Color fundus image. 2346 x 1568 pixels. 45-degree field of view: 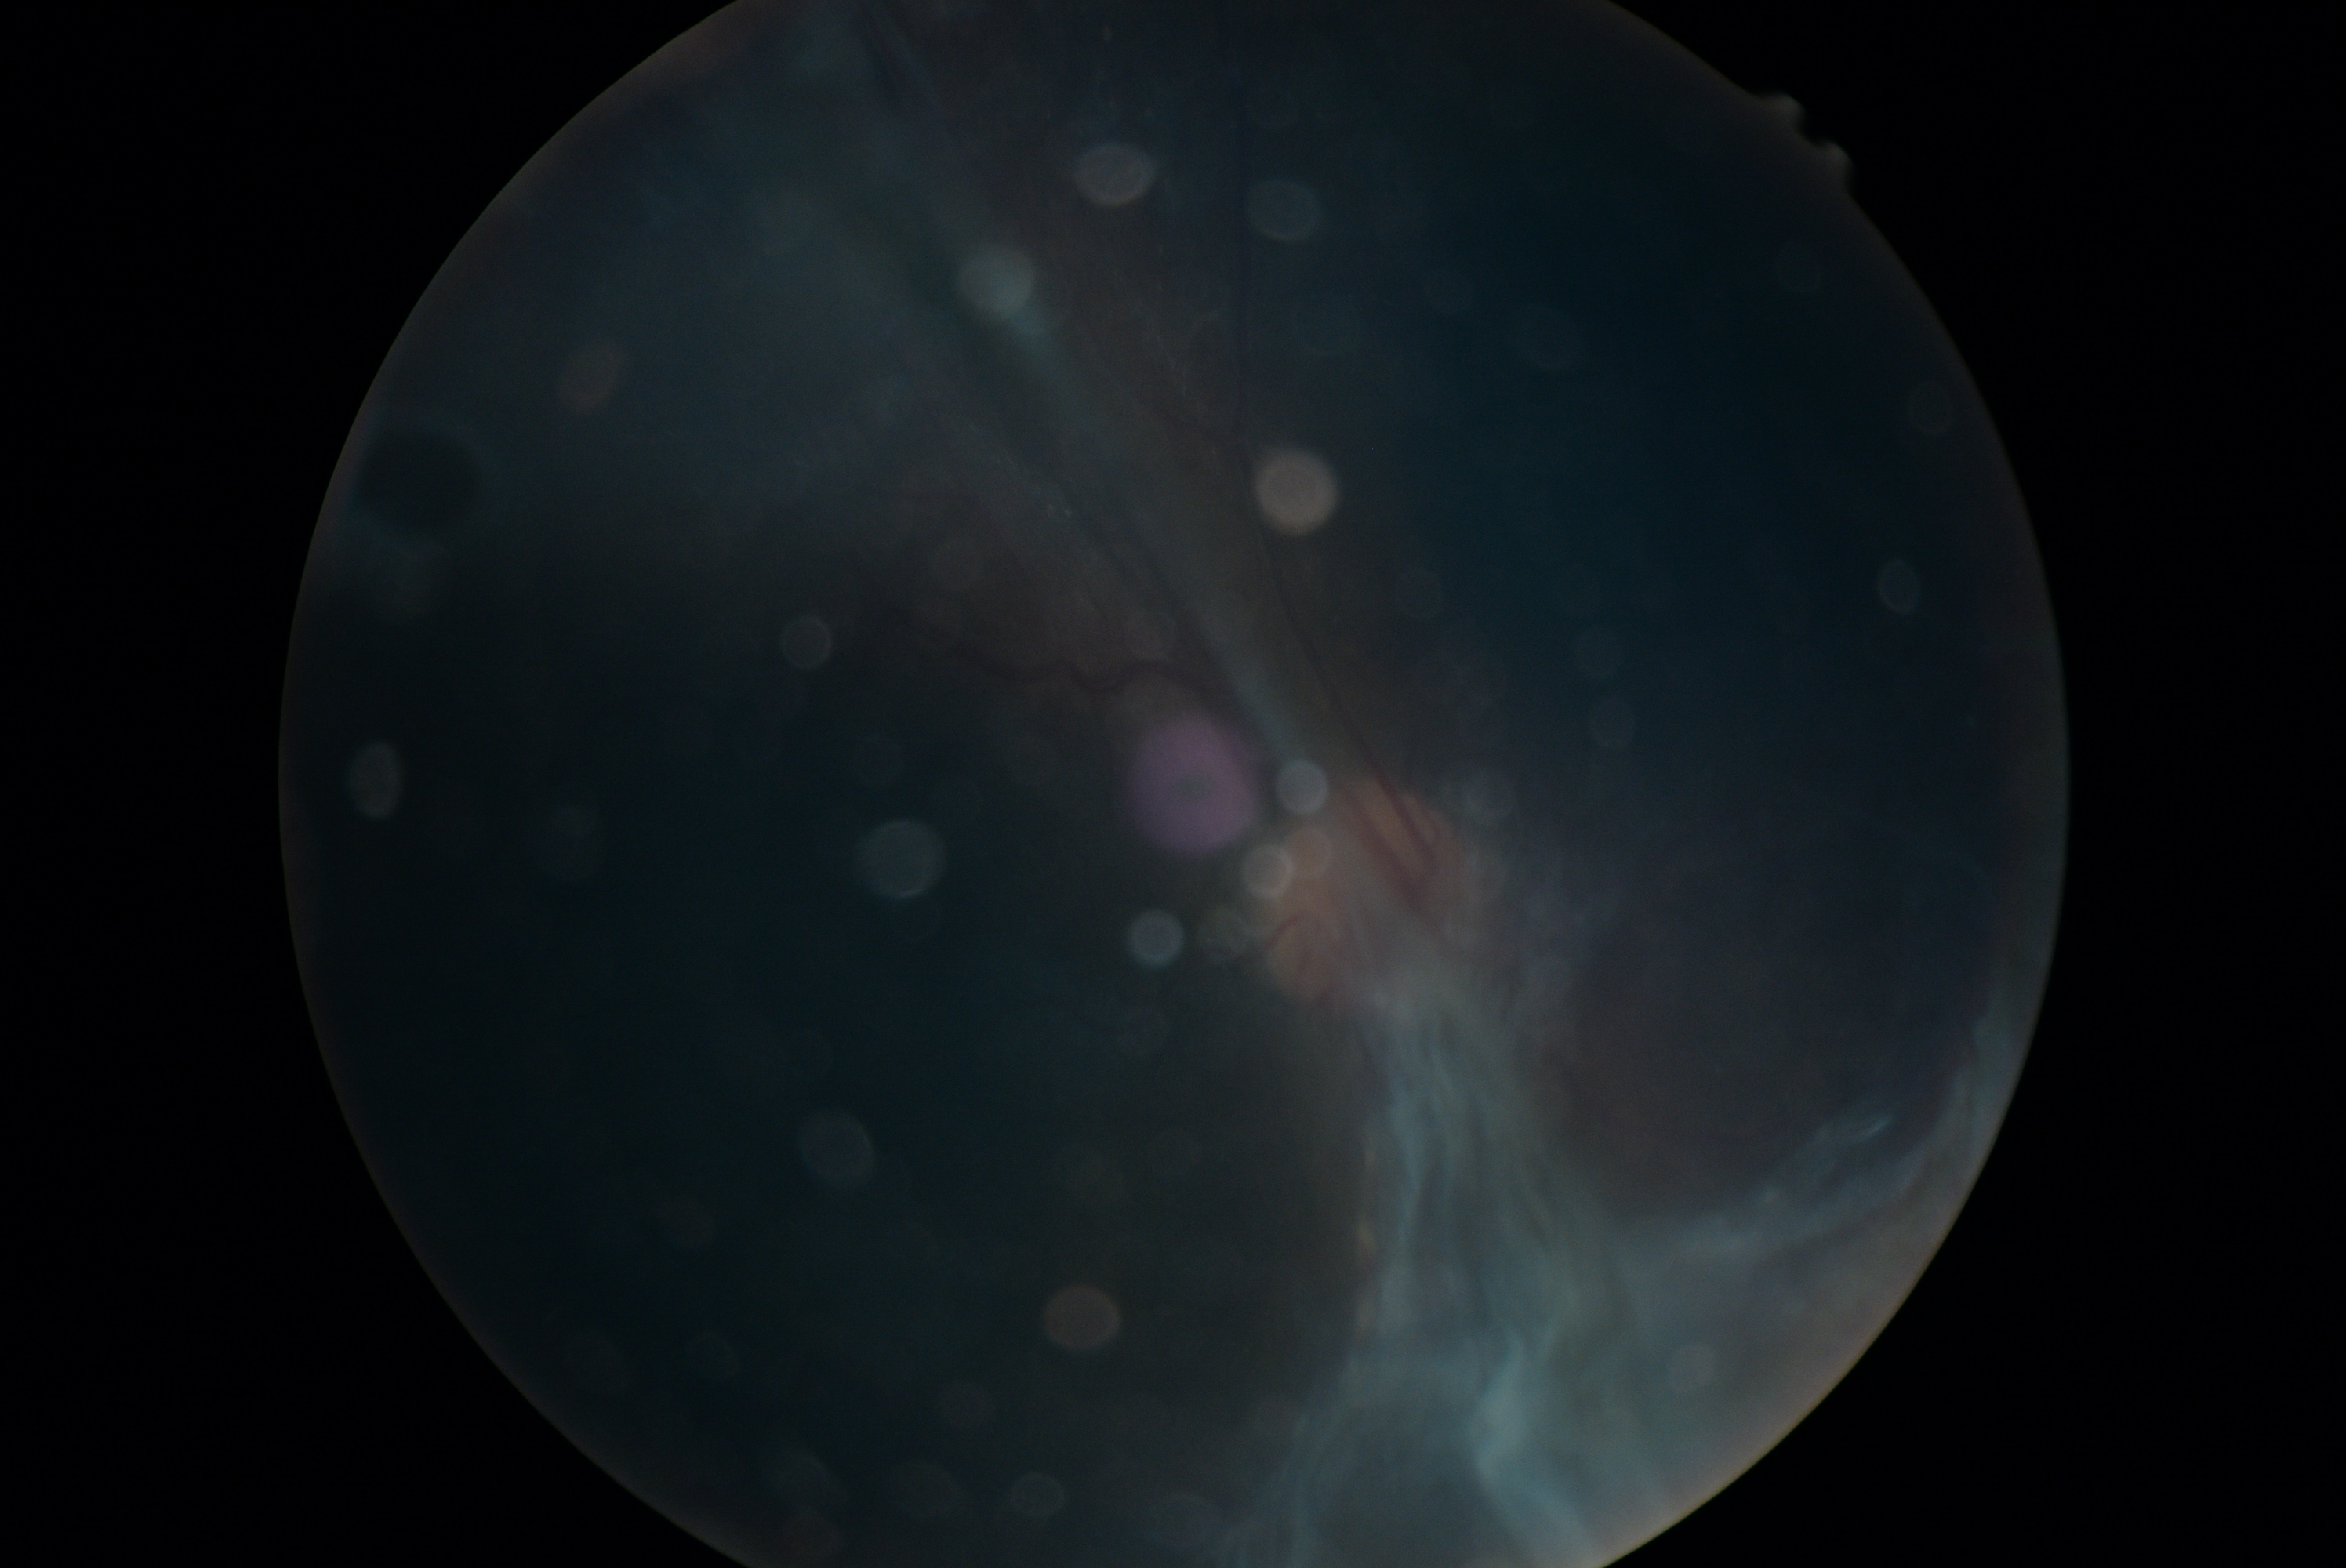

DR stage@proliferative diabetic retinopathy (grade 4), DR class@proliferative diabetic retinopathy.